Davis DR grading.
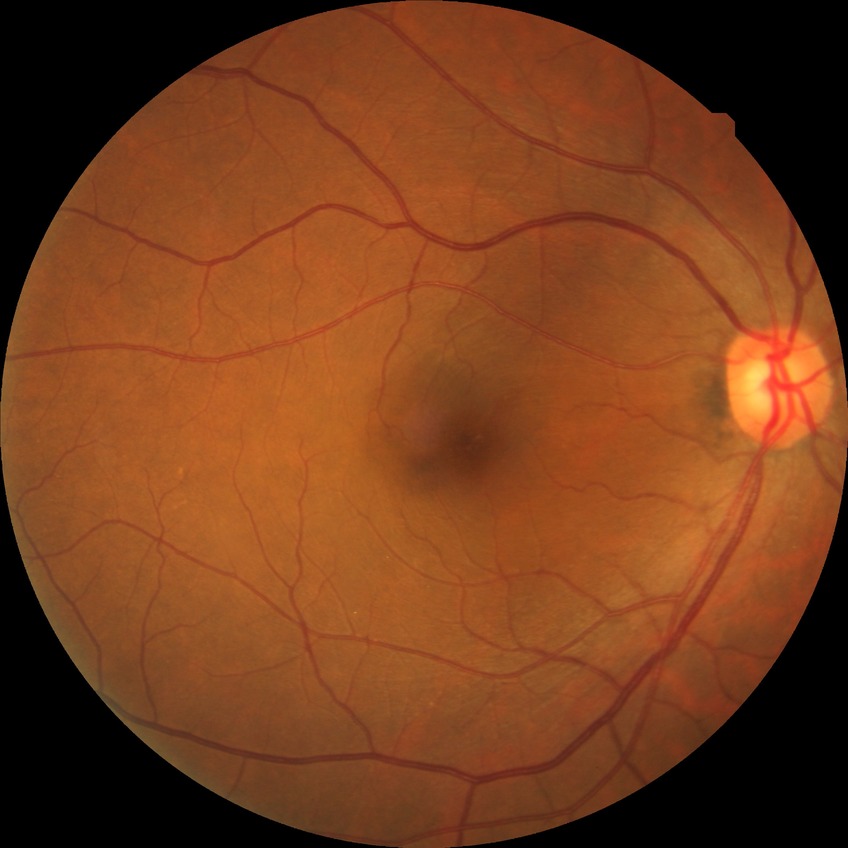   davis_grade: no diabetic retinopathy (NDR)